Color fundus image. FOV: 45 degrees
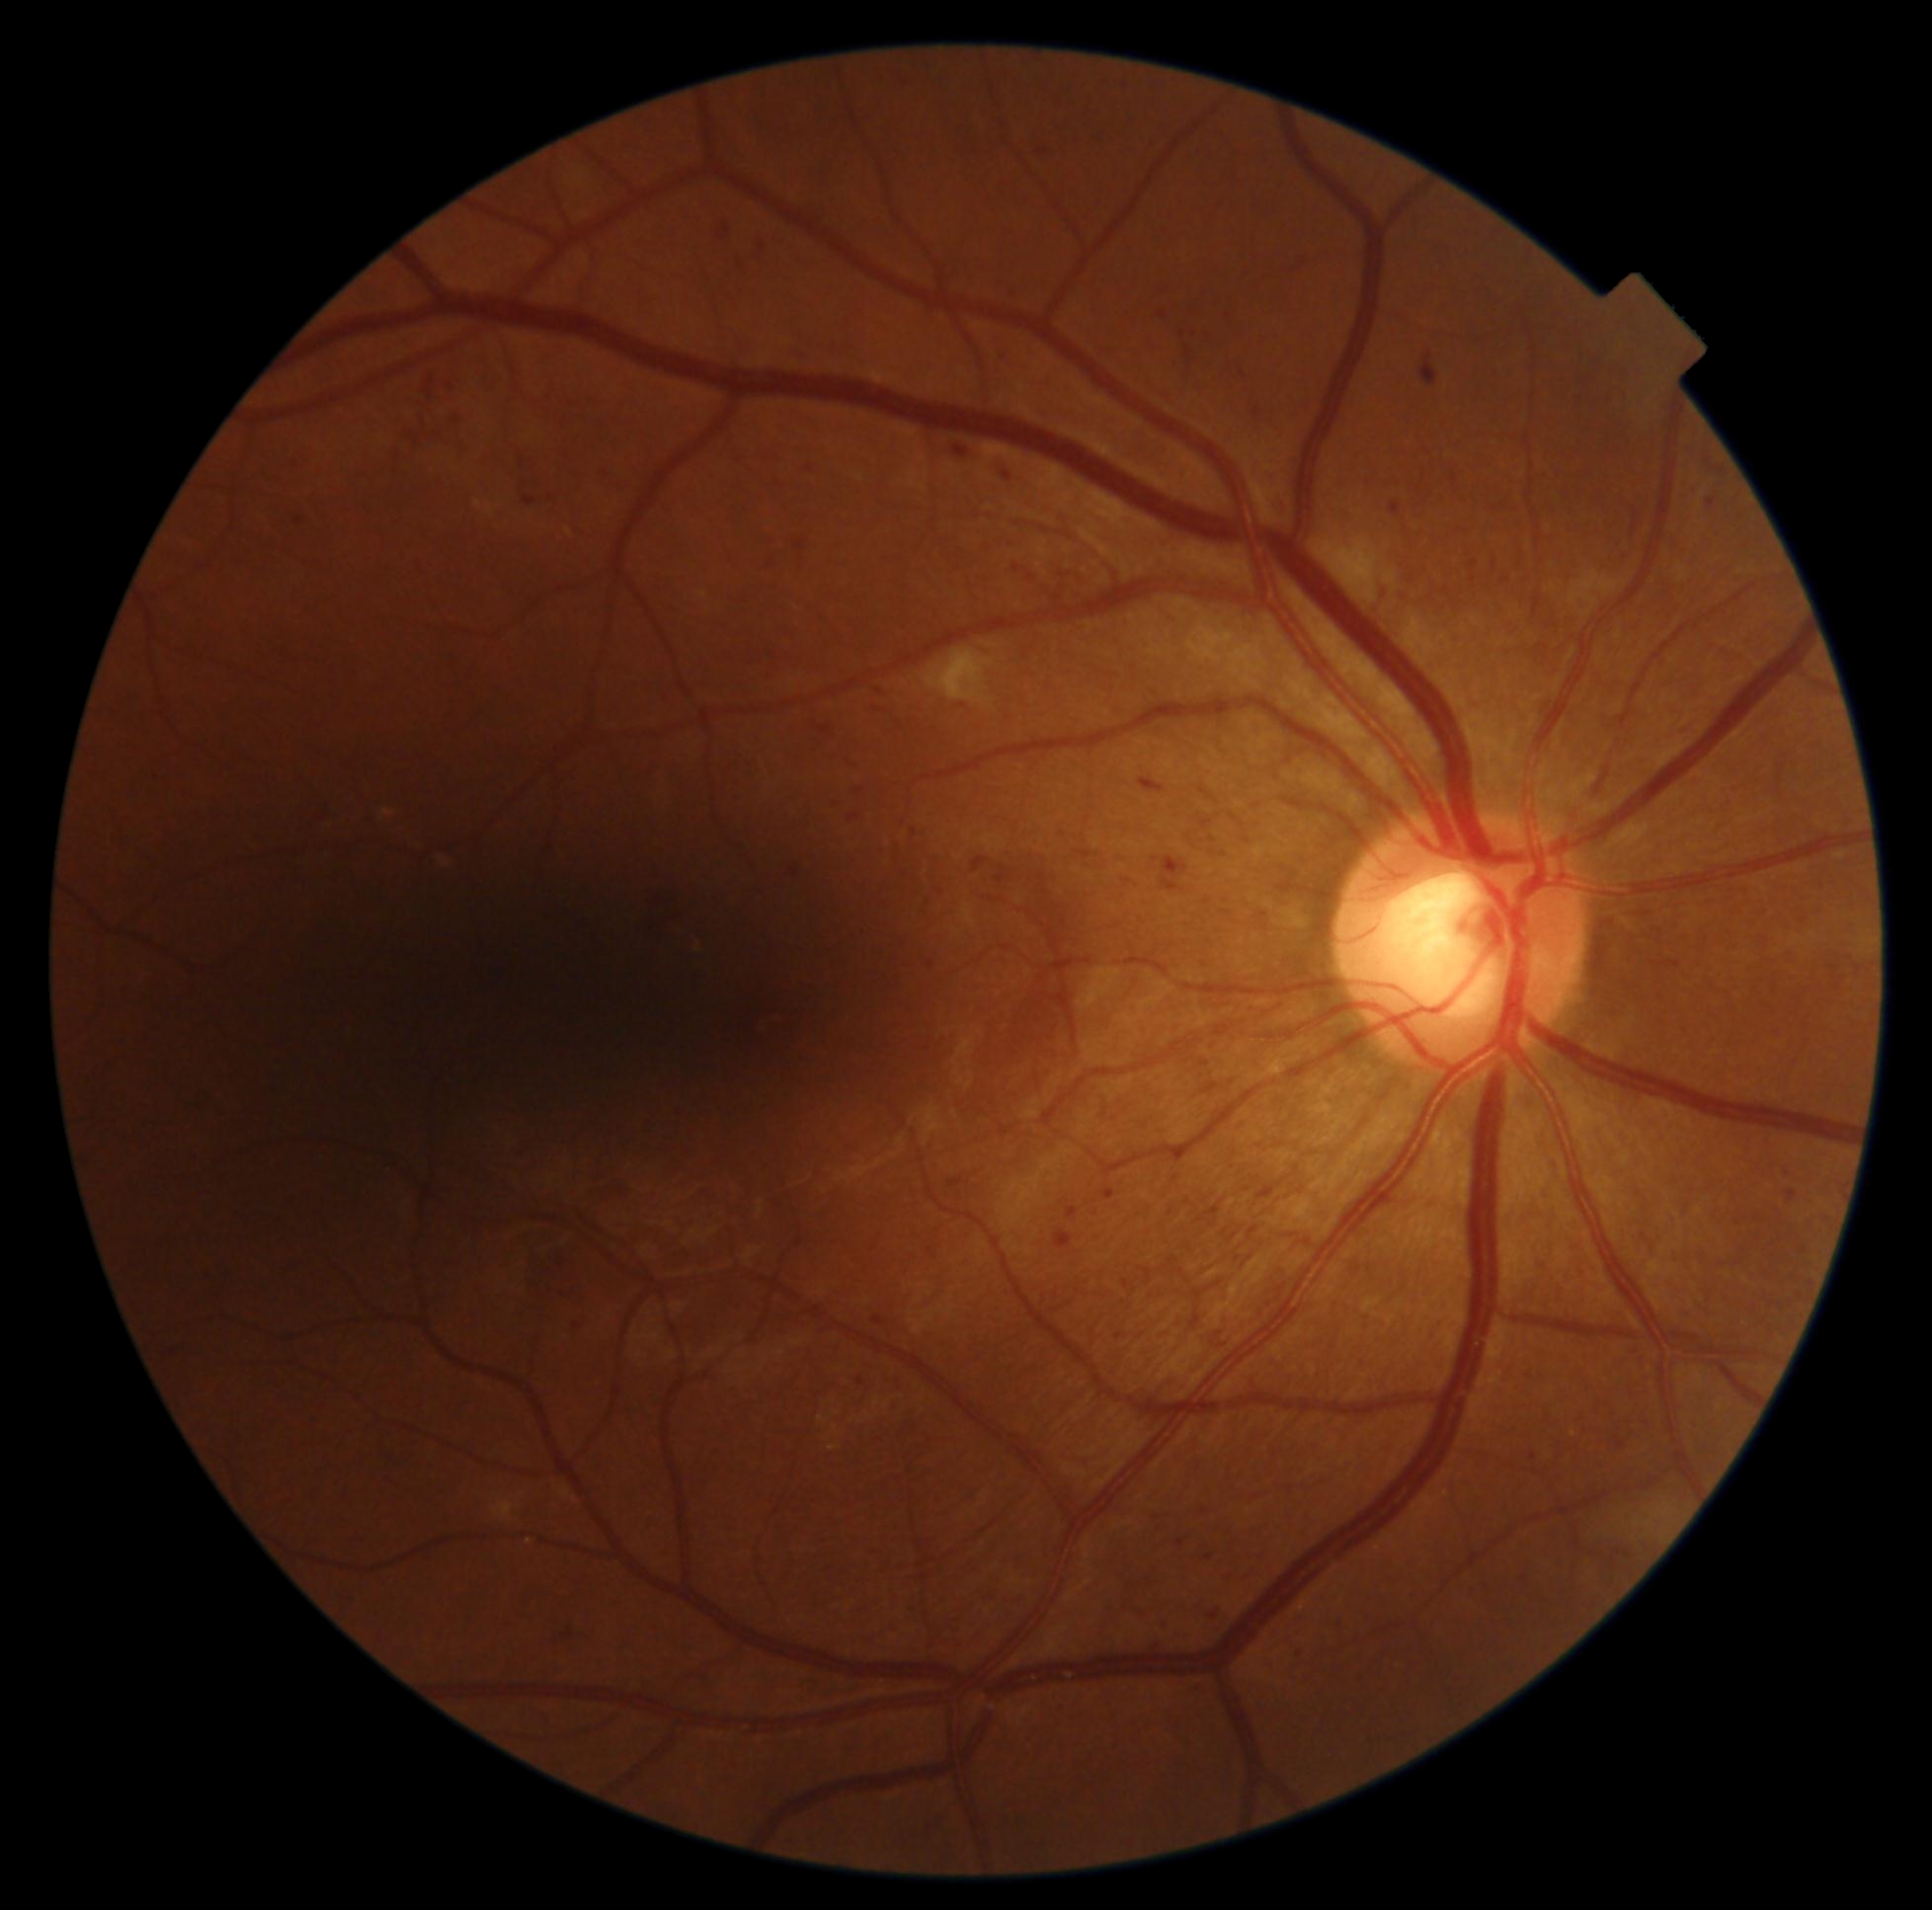 partial: true
dr_grade: 2
dr_grade_name: moderate NPDR
lesions:
  ma:
    - 1077/849/1094/860
    - 954/446/969/457
    - 1420/354/1438/387
    - 1005/473/1011/481
    - 1340/1623/1347/1632
    - 454/418/462/425
    - 1176/1539/1186/1550
    - 1390/502/1403/517
    - 973/856/989/873
    - 1196/816/1213/830
    - 1200/1059/1211/1068
    - 949/1179/965/1188
  ma_small:
    - 900, 727
    - 1711, 466
    - 1122, 711
    - 941, 891
    - 1119, 1336